1240x1240. Pediatric wide-field fundus photograph: 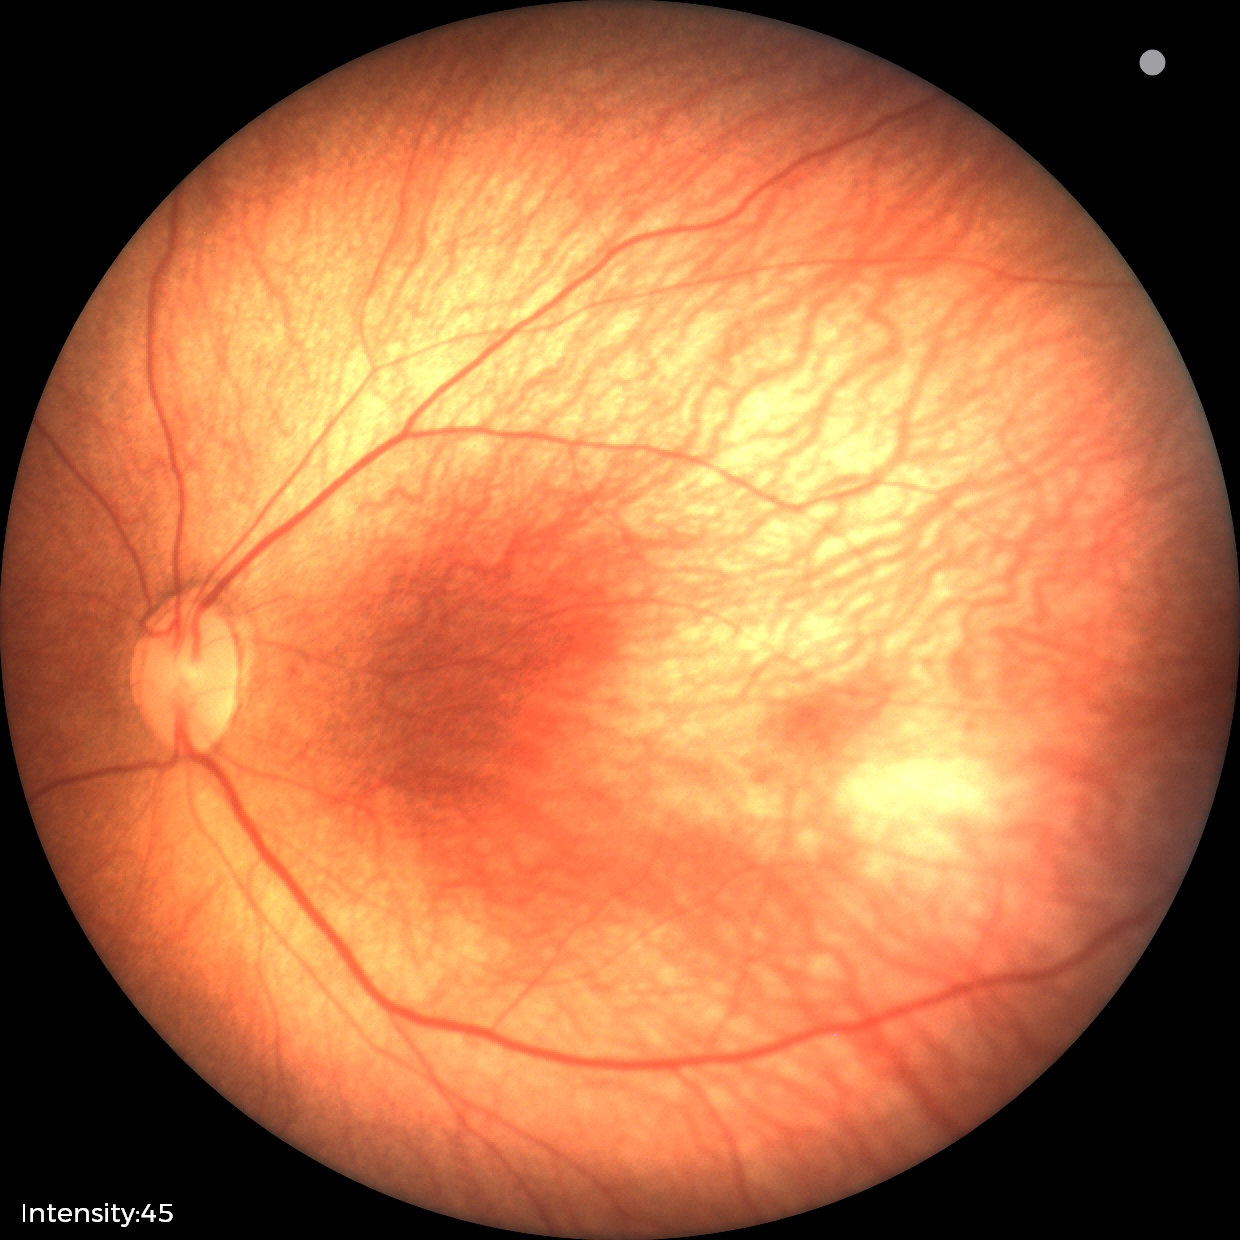
Plus form = absent | impression = retinopathy of prematurity stage 1.